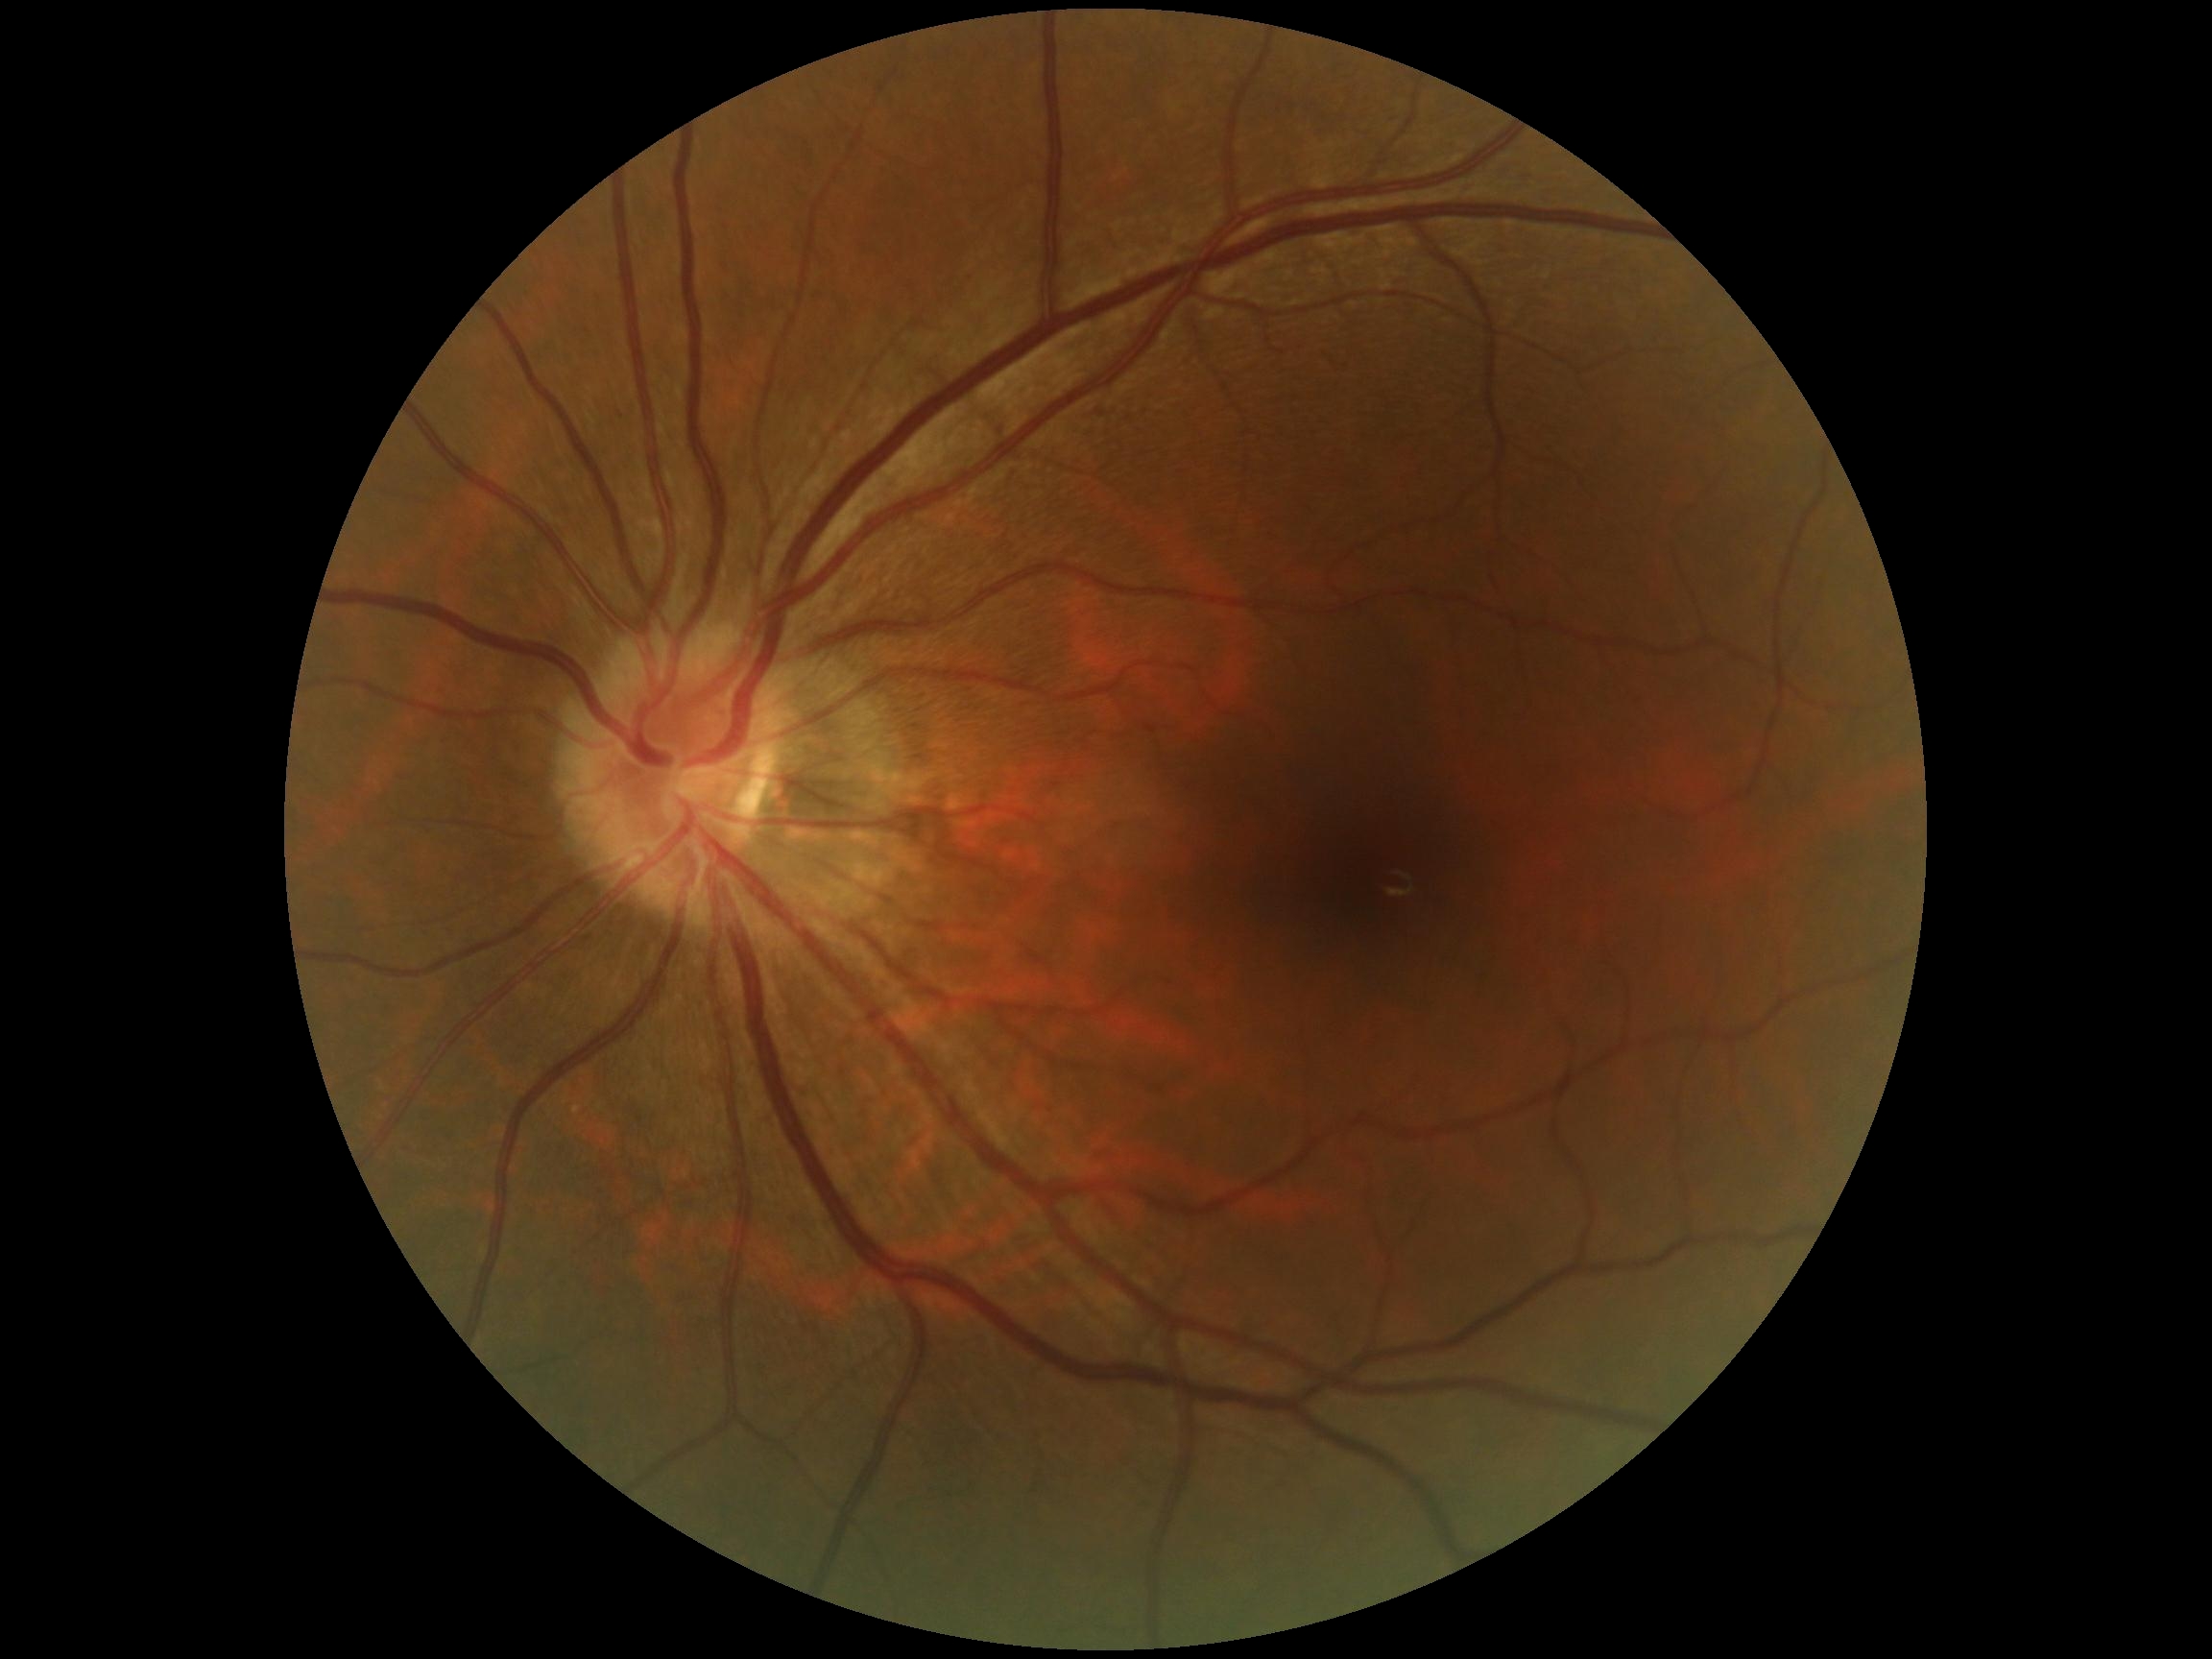
{
  "dr_grade": "grade 0 (no apparent retinopathy)"
}